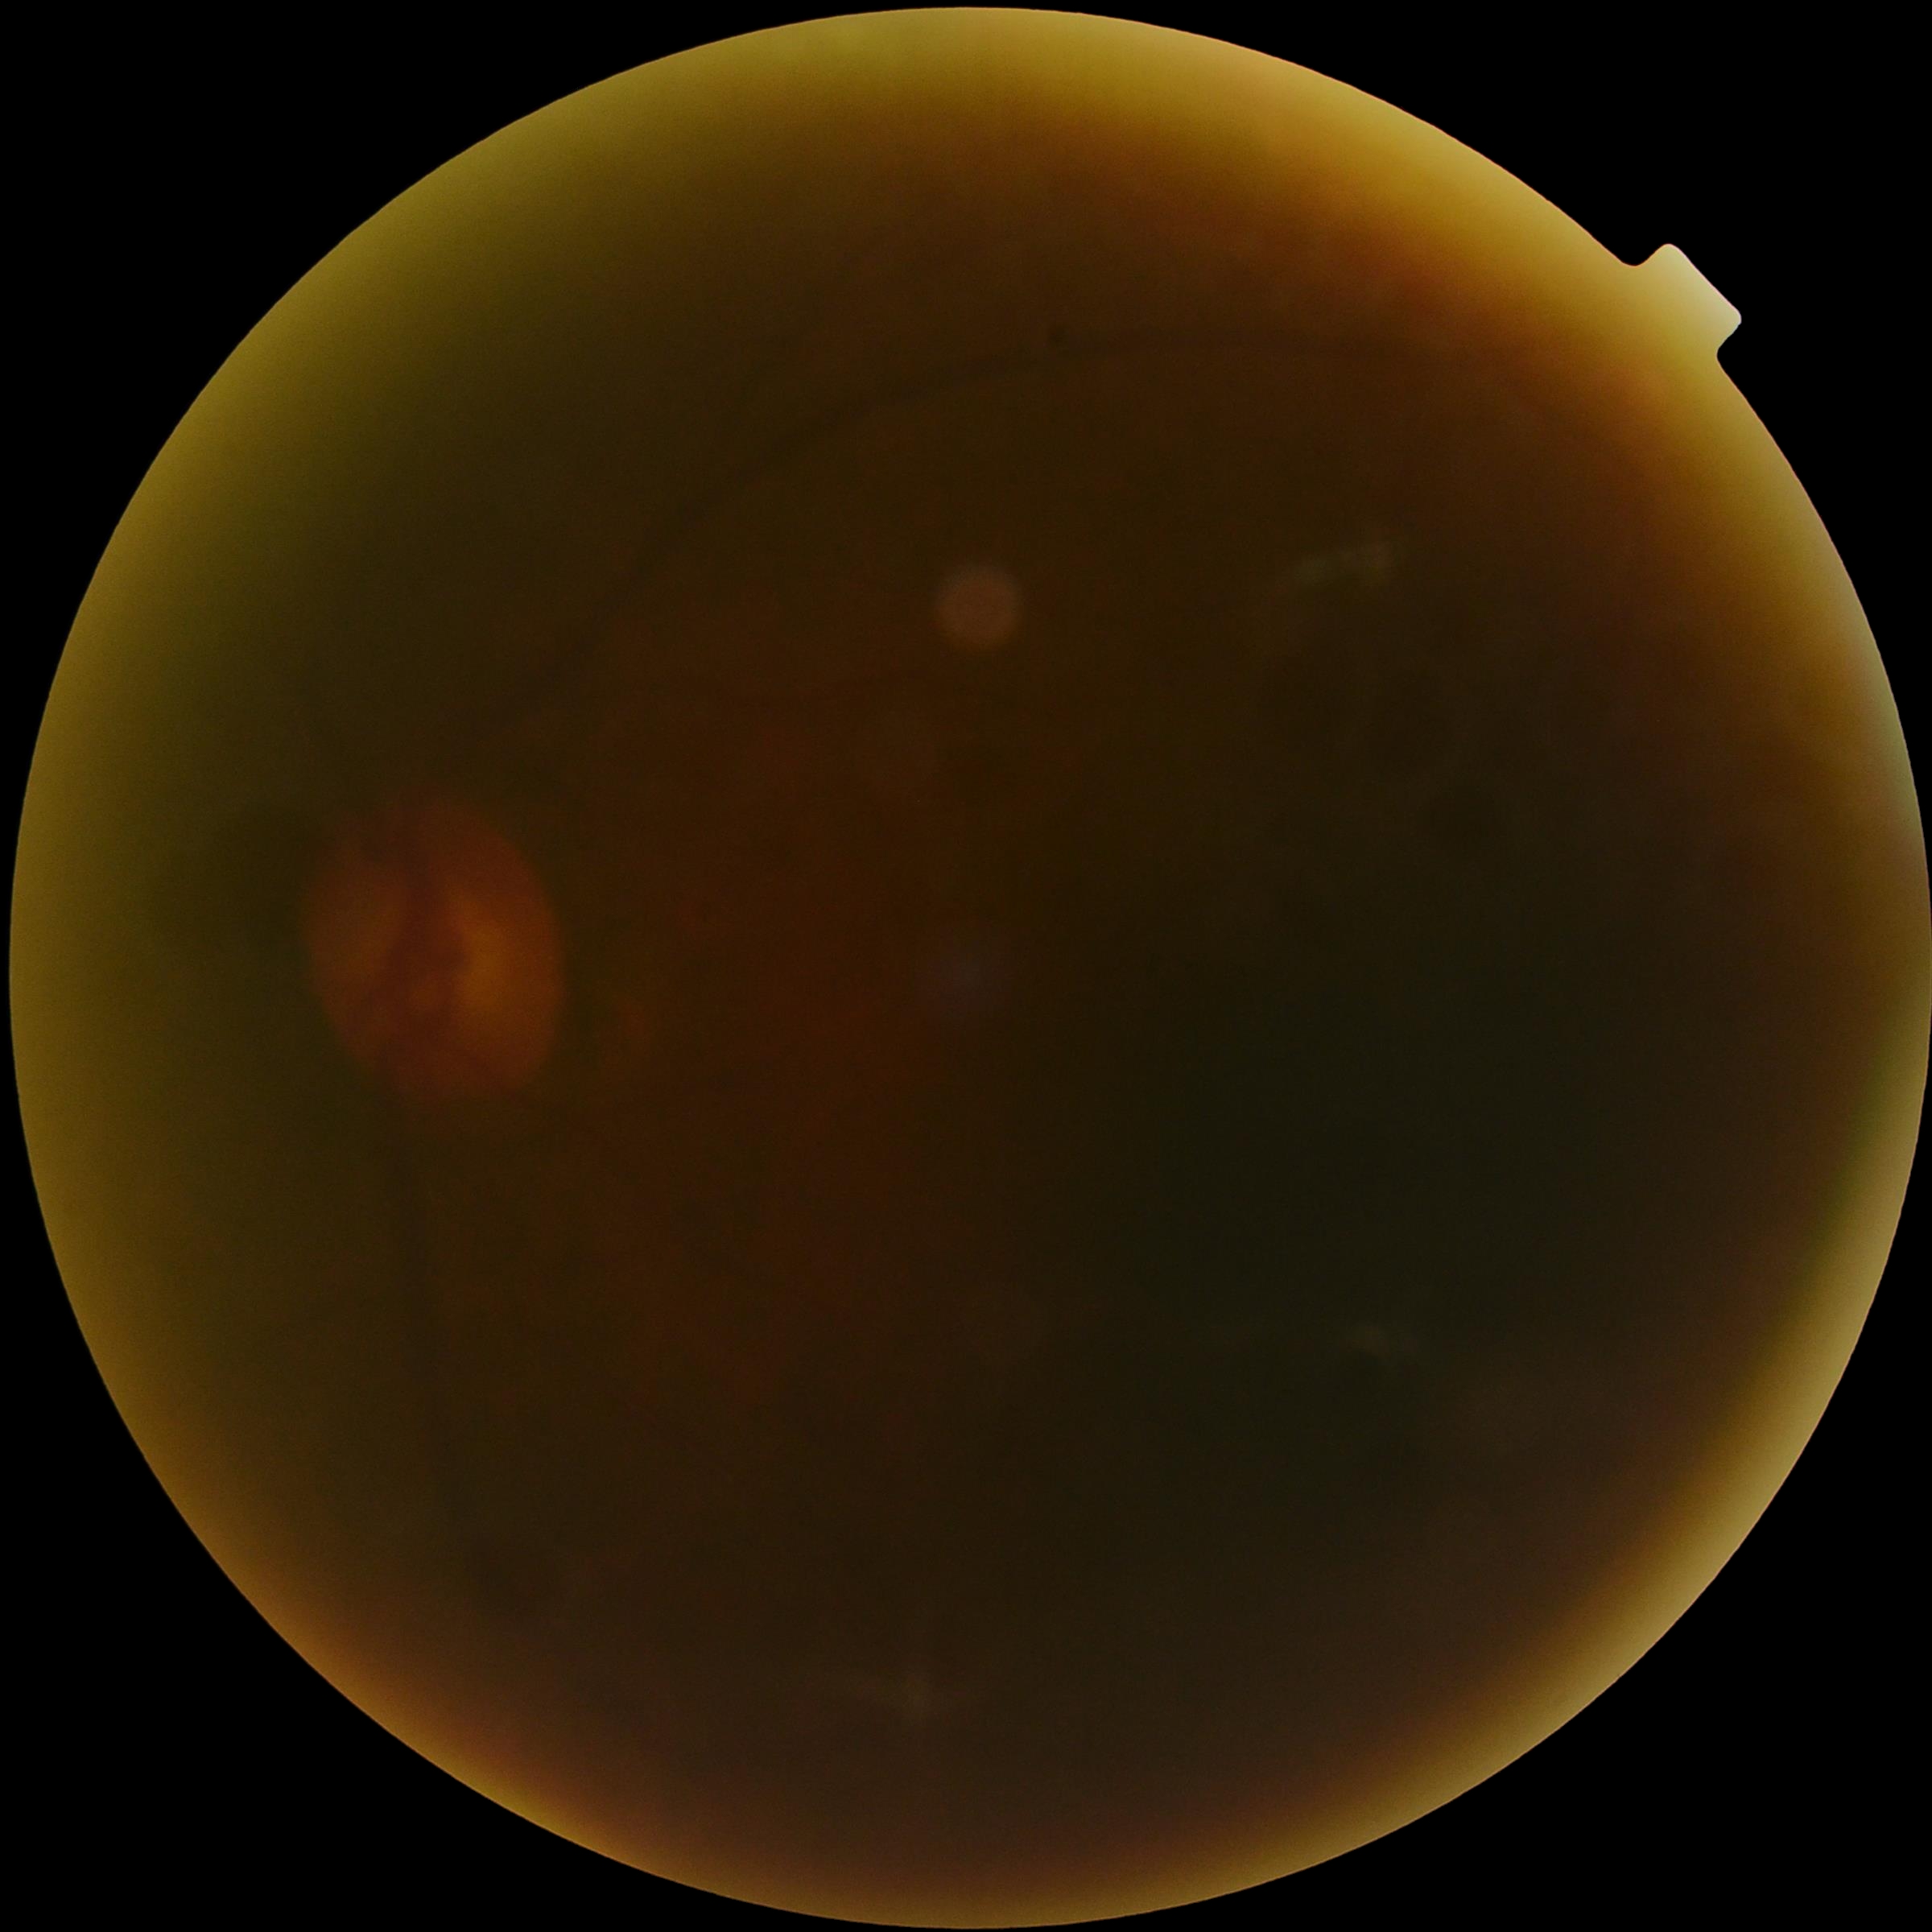 The image cannot be graded for diabetic retinopathy. Diabetic retinopathy: ungradable due to poor image quality.